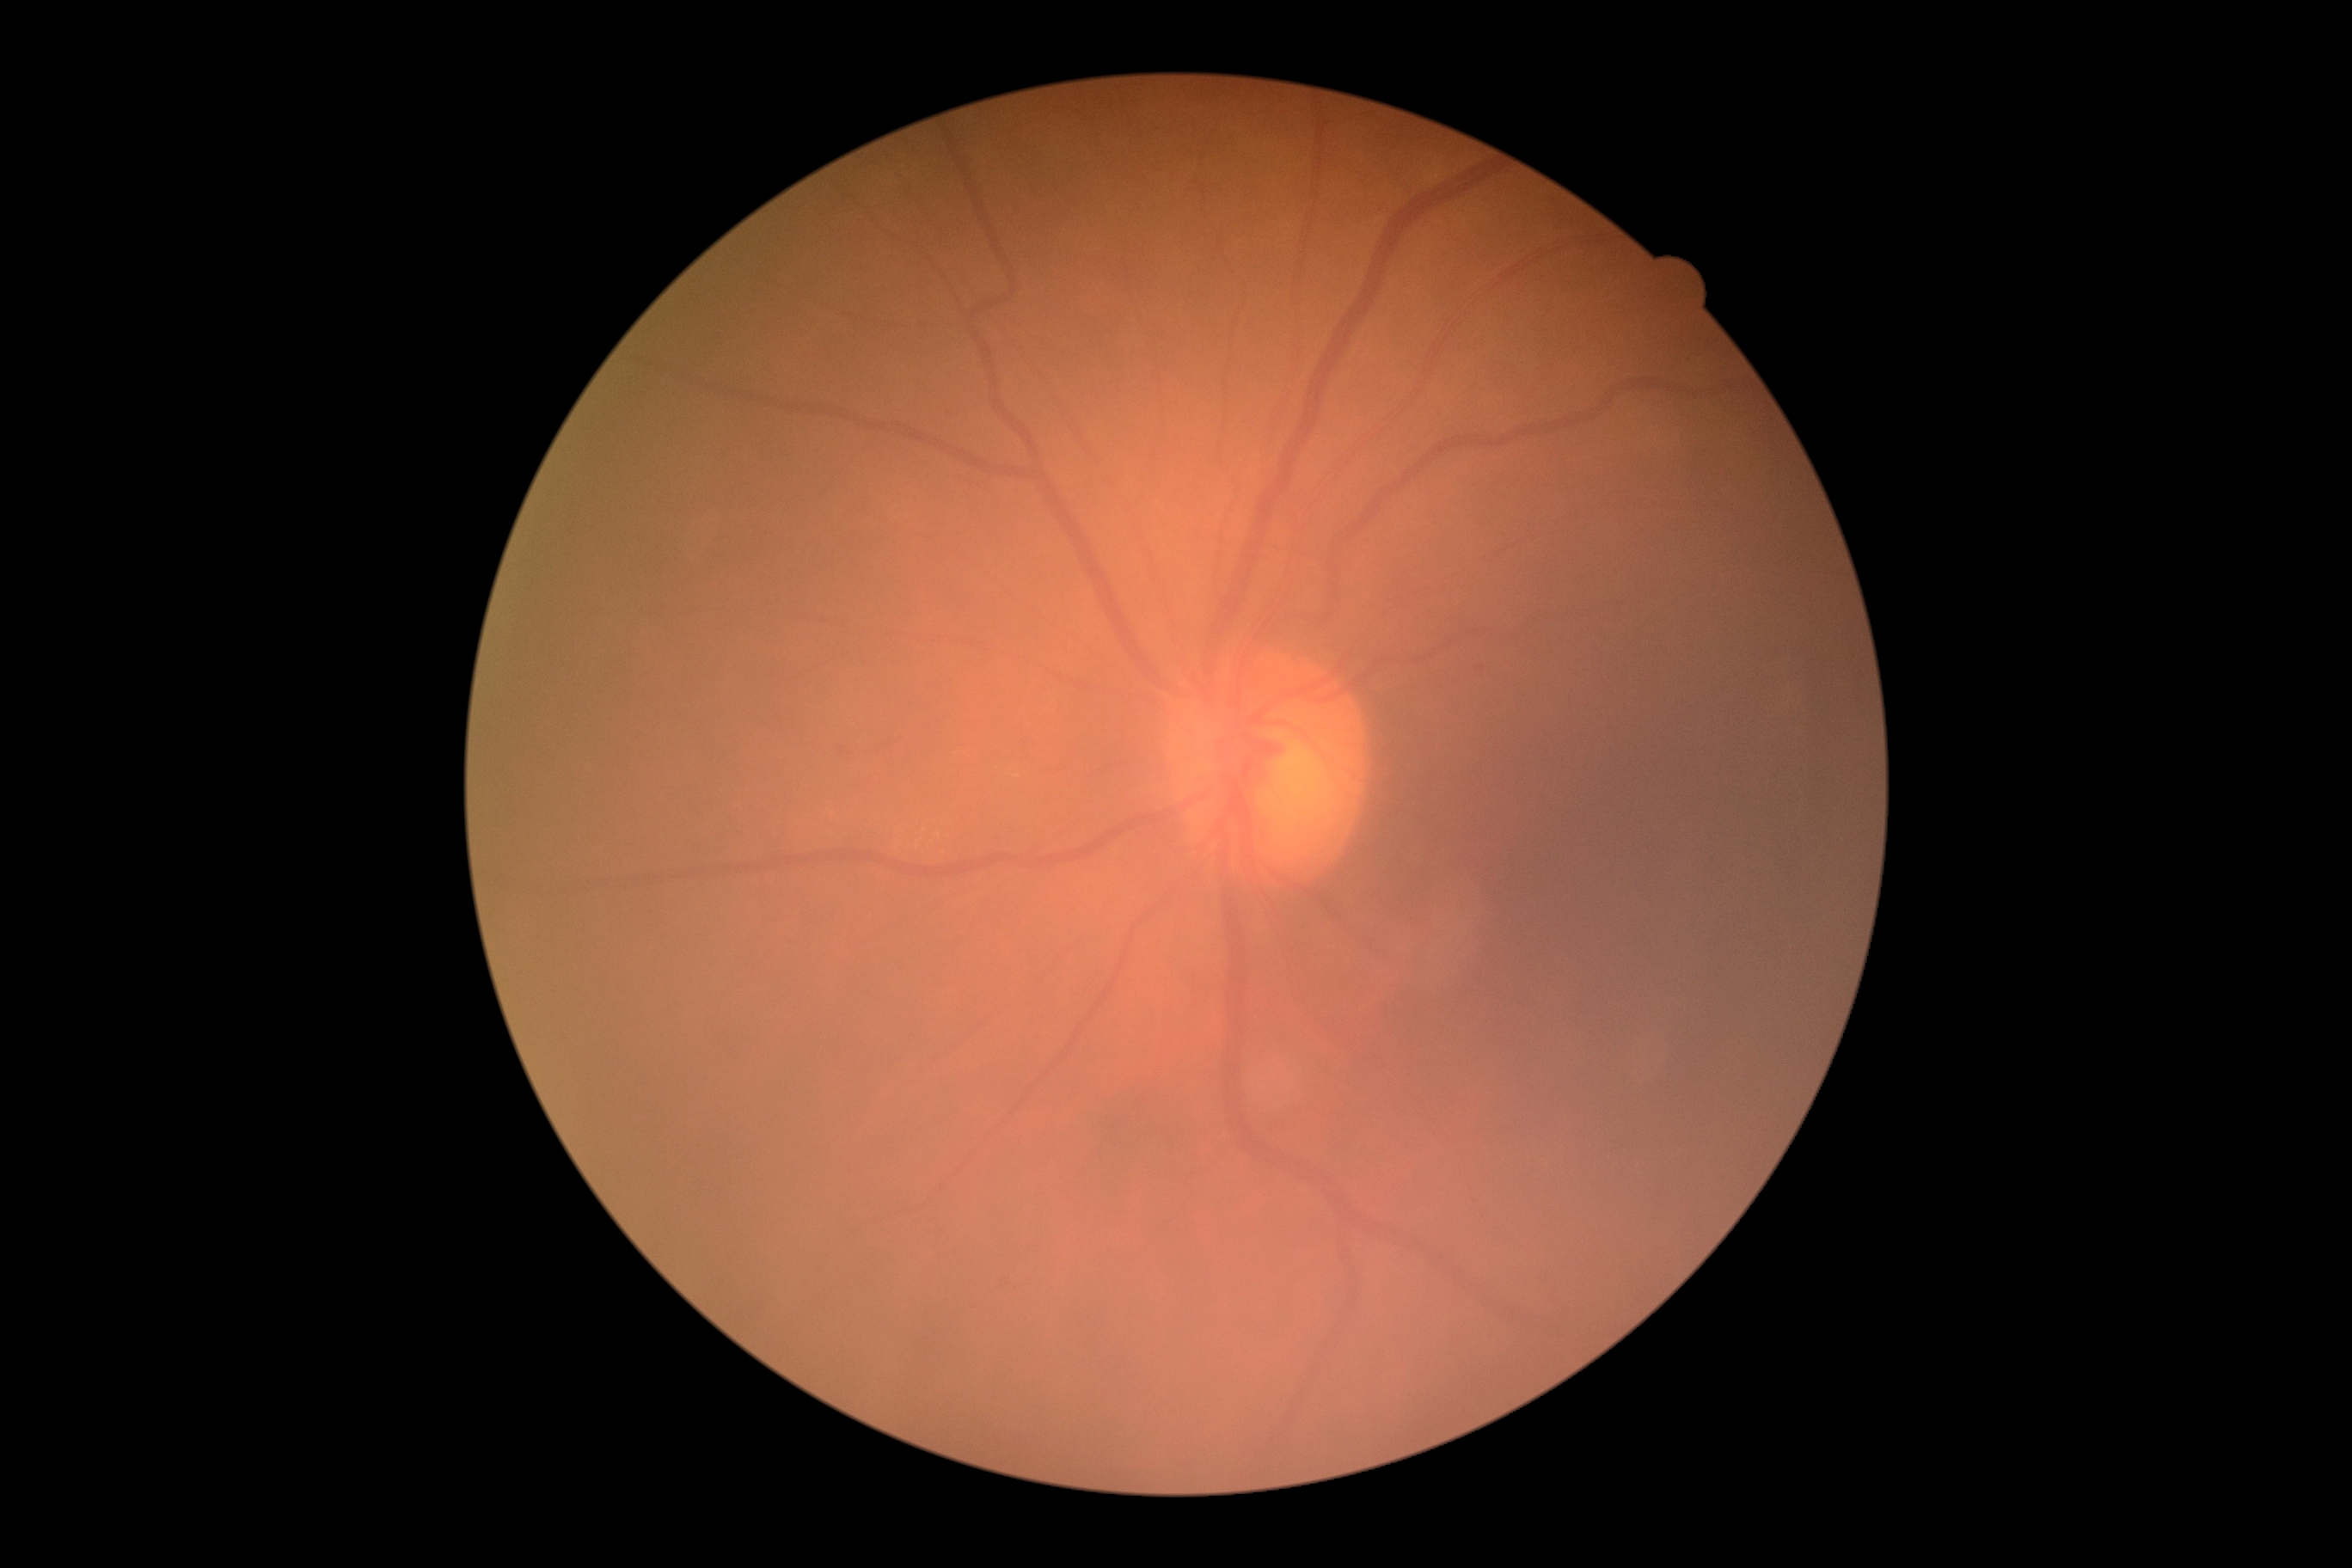

diabetic retinopathy grade: 0.